2048x1536px:
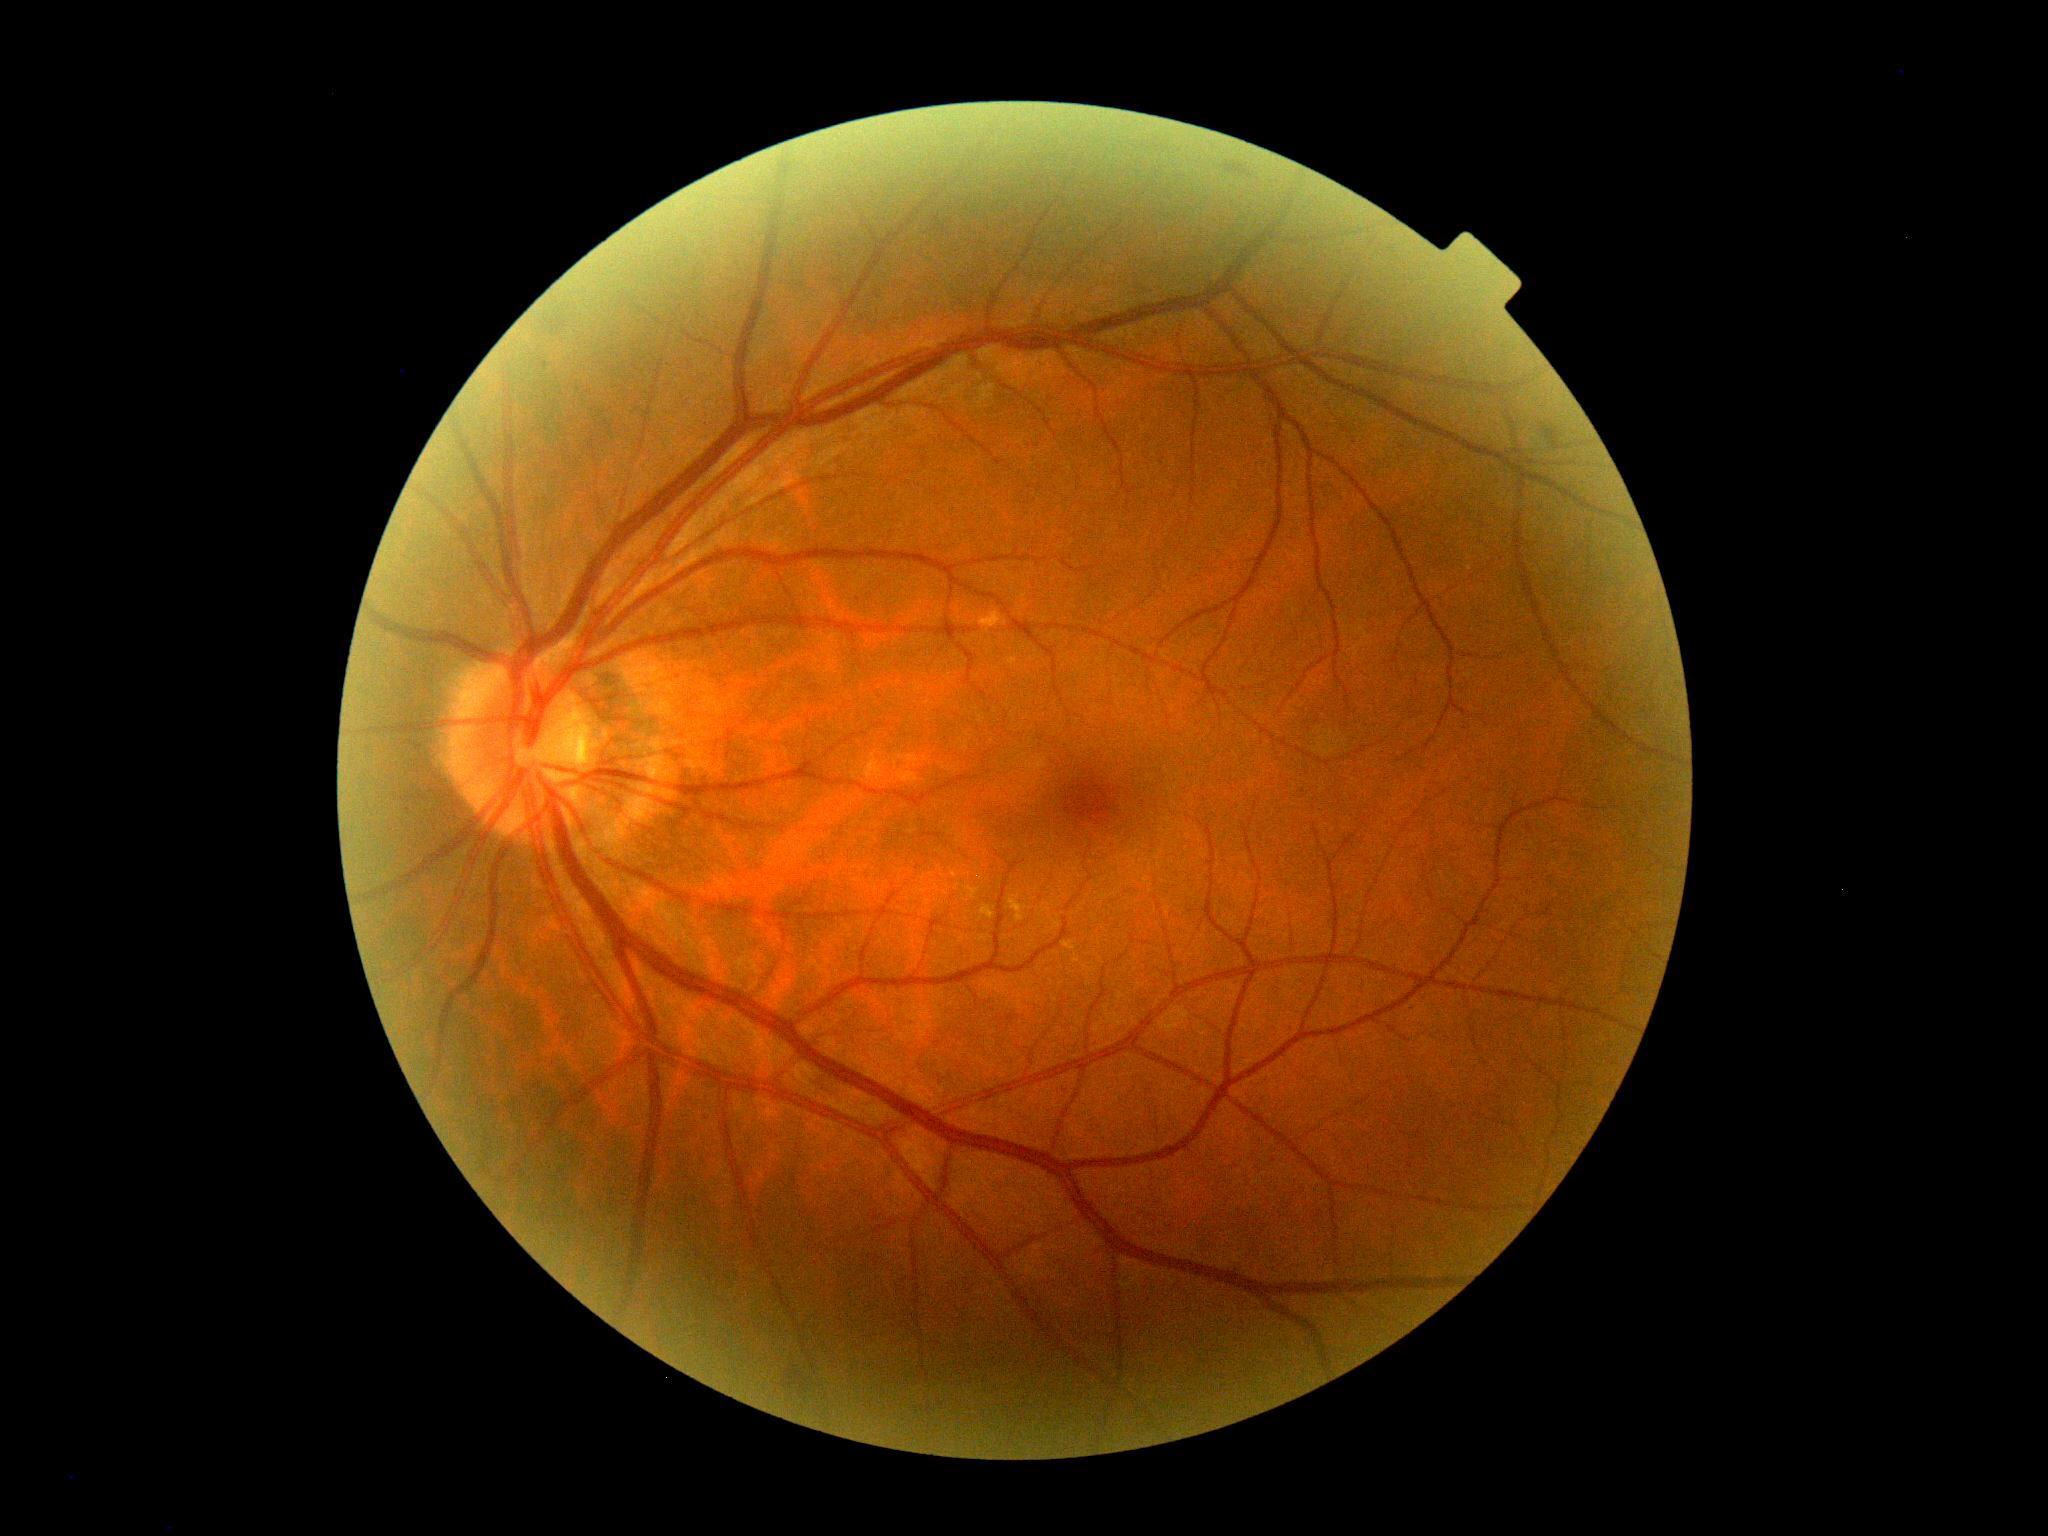
DR grade: no apparent retinopathy (0) — no visible signs of diabetic retinopathy.